2352 by 1568 pixels.
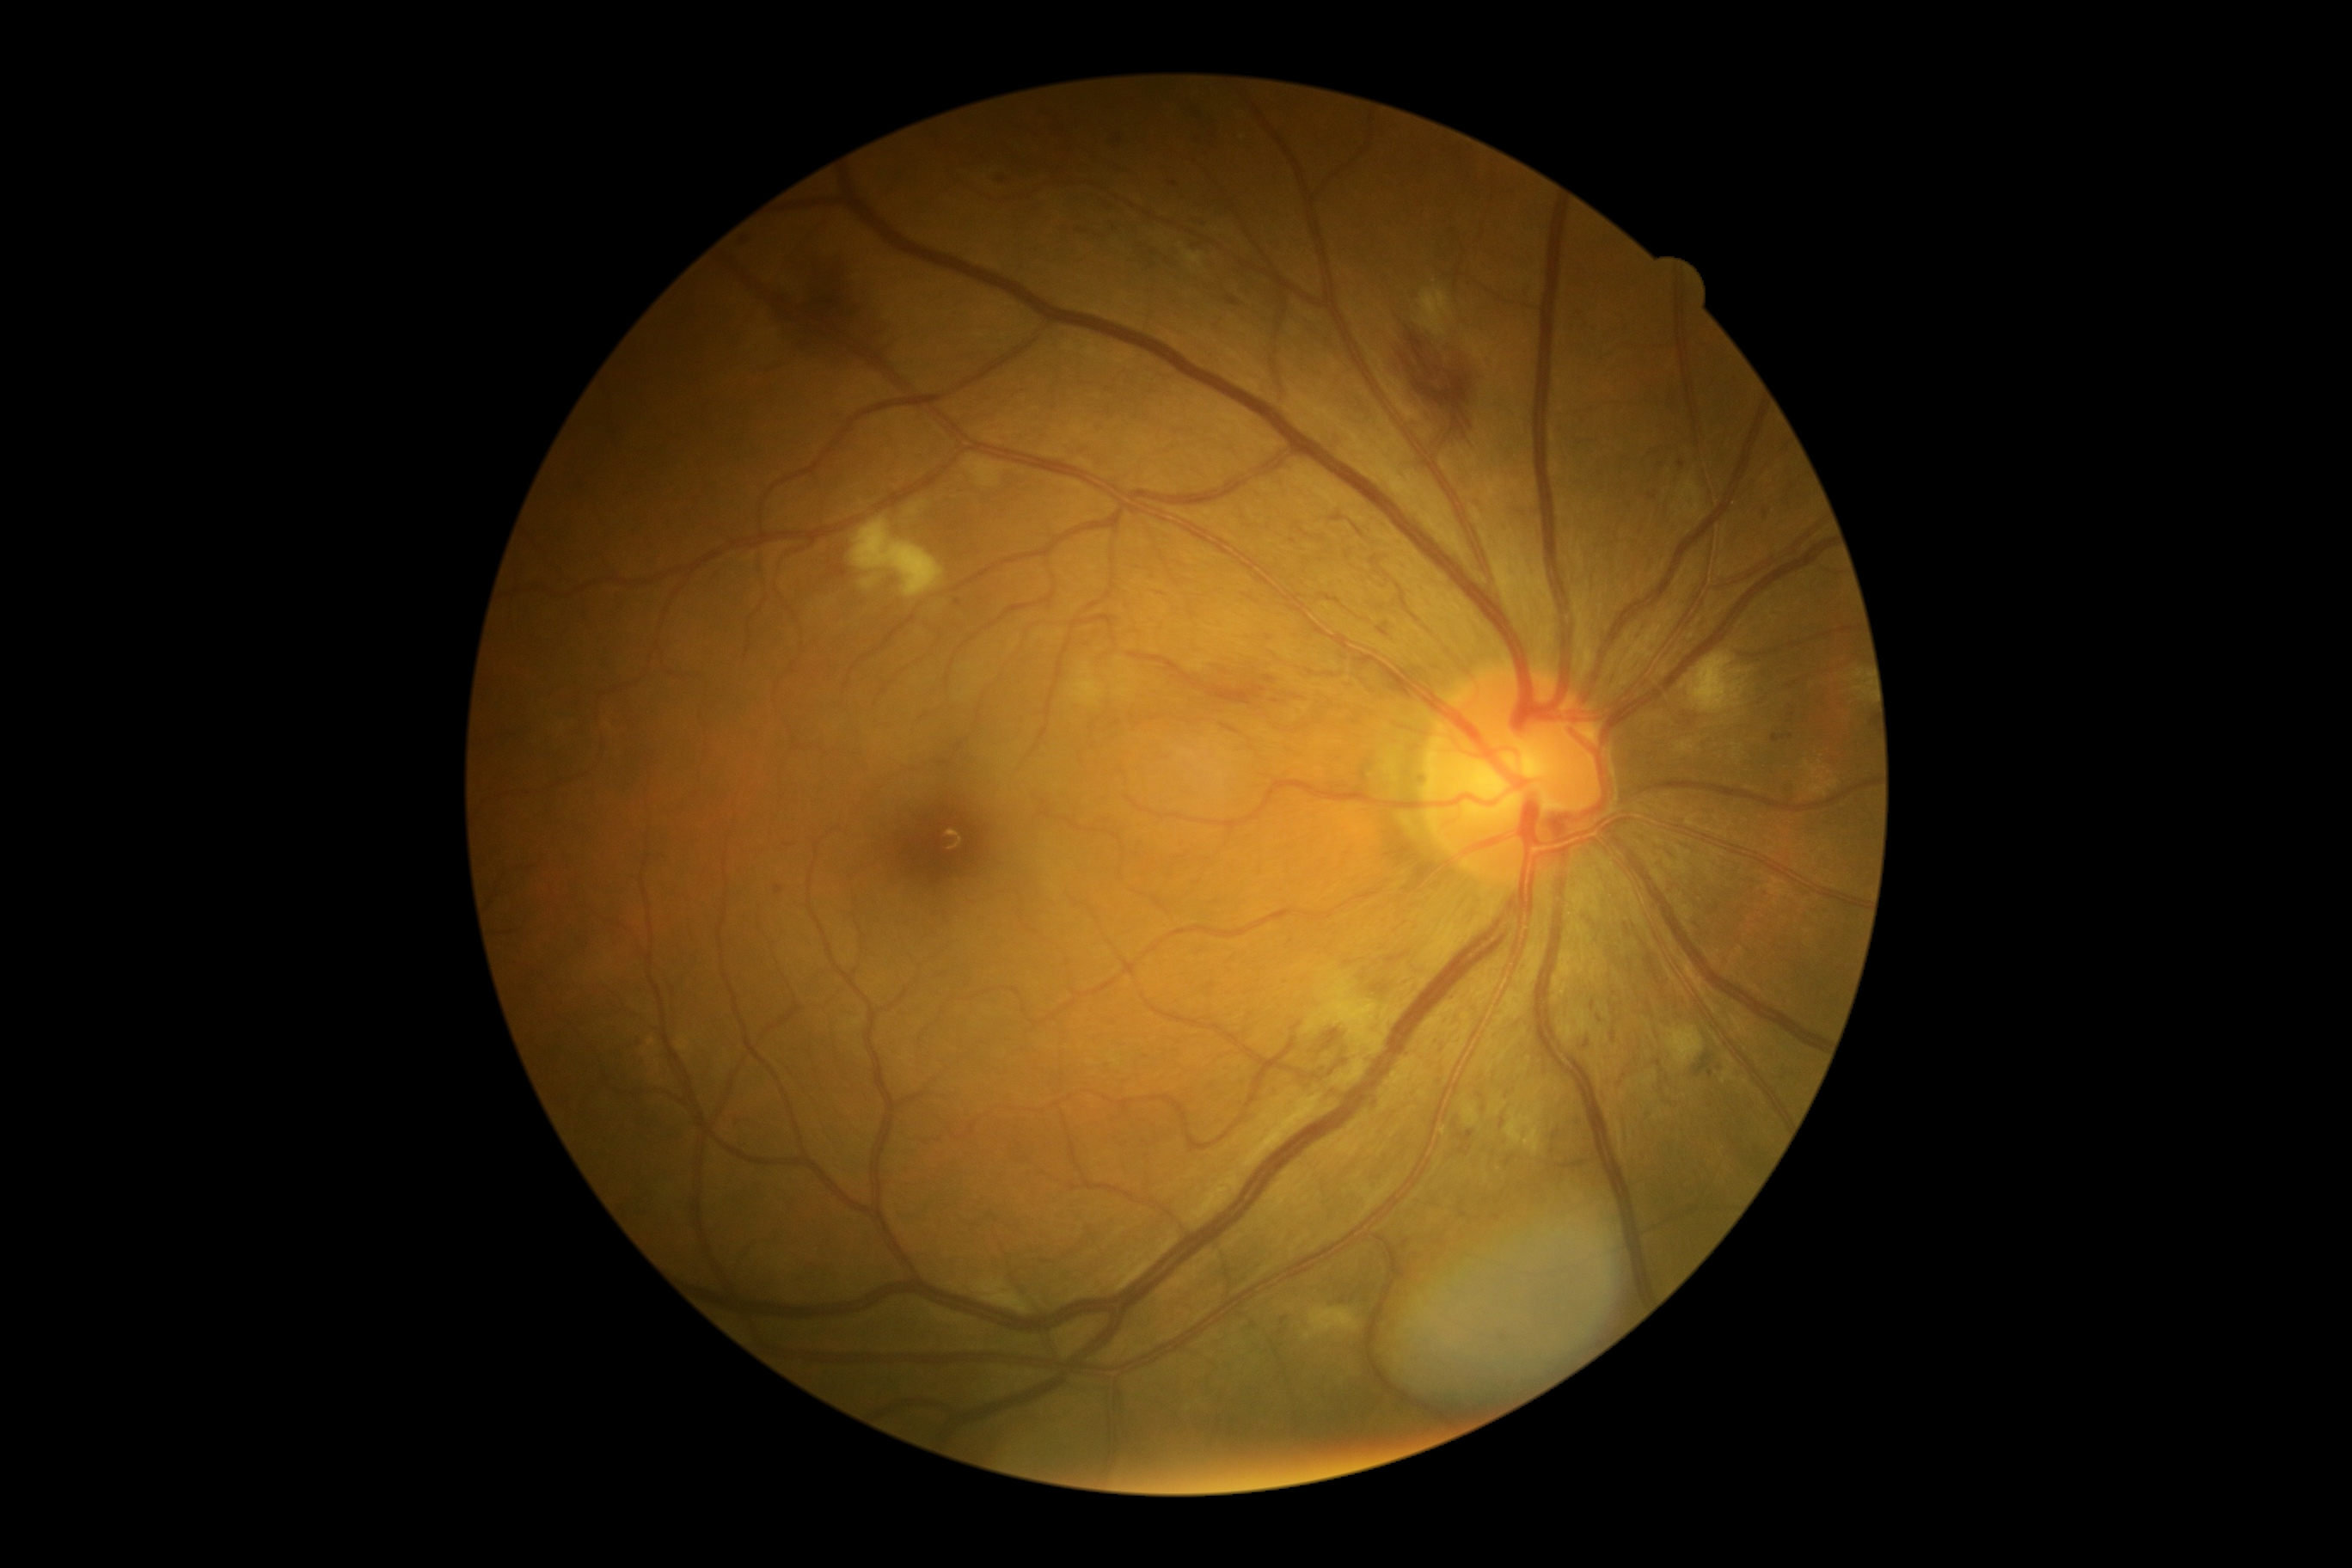 DR severity is grade 2.